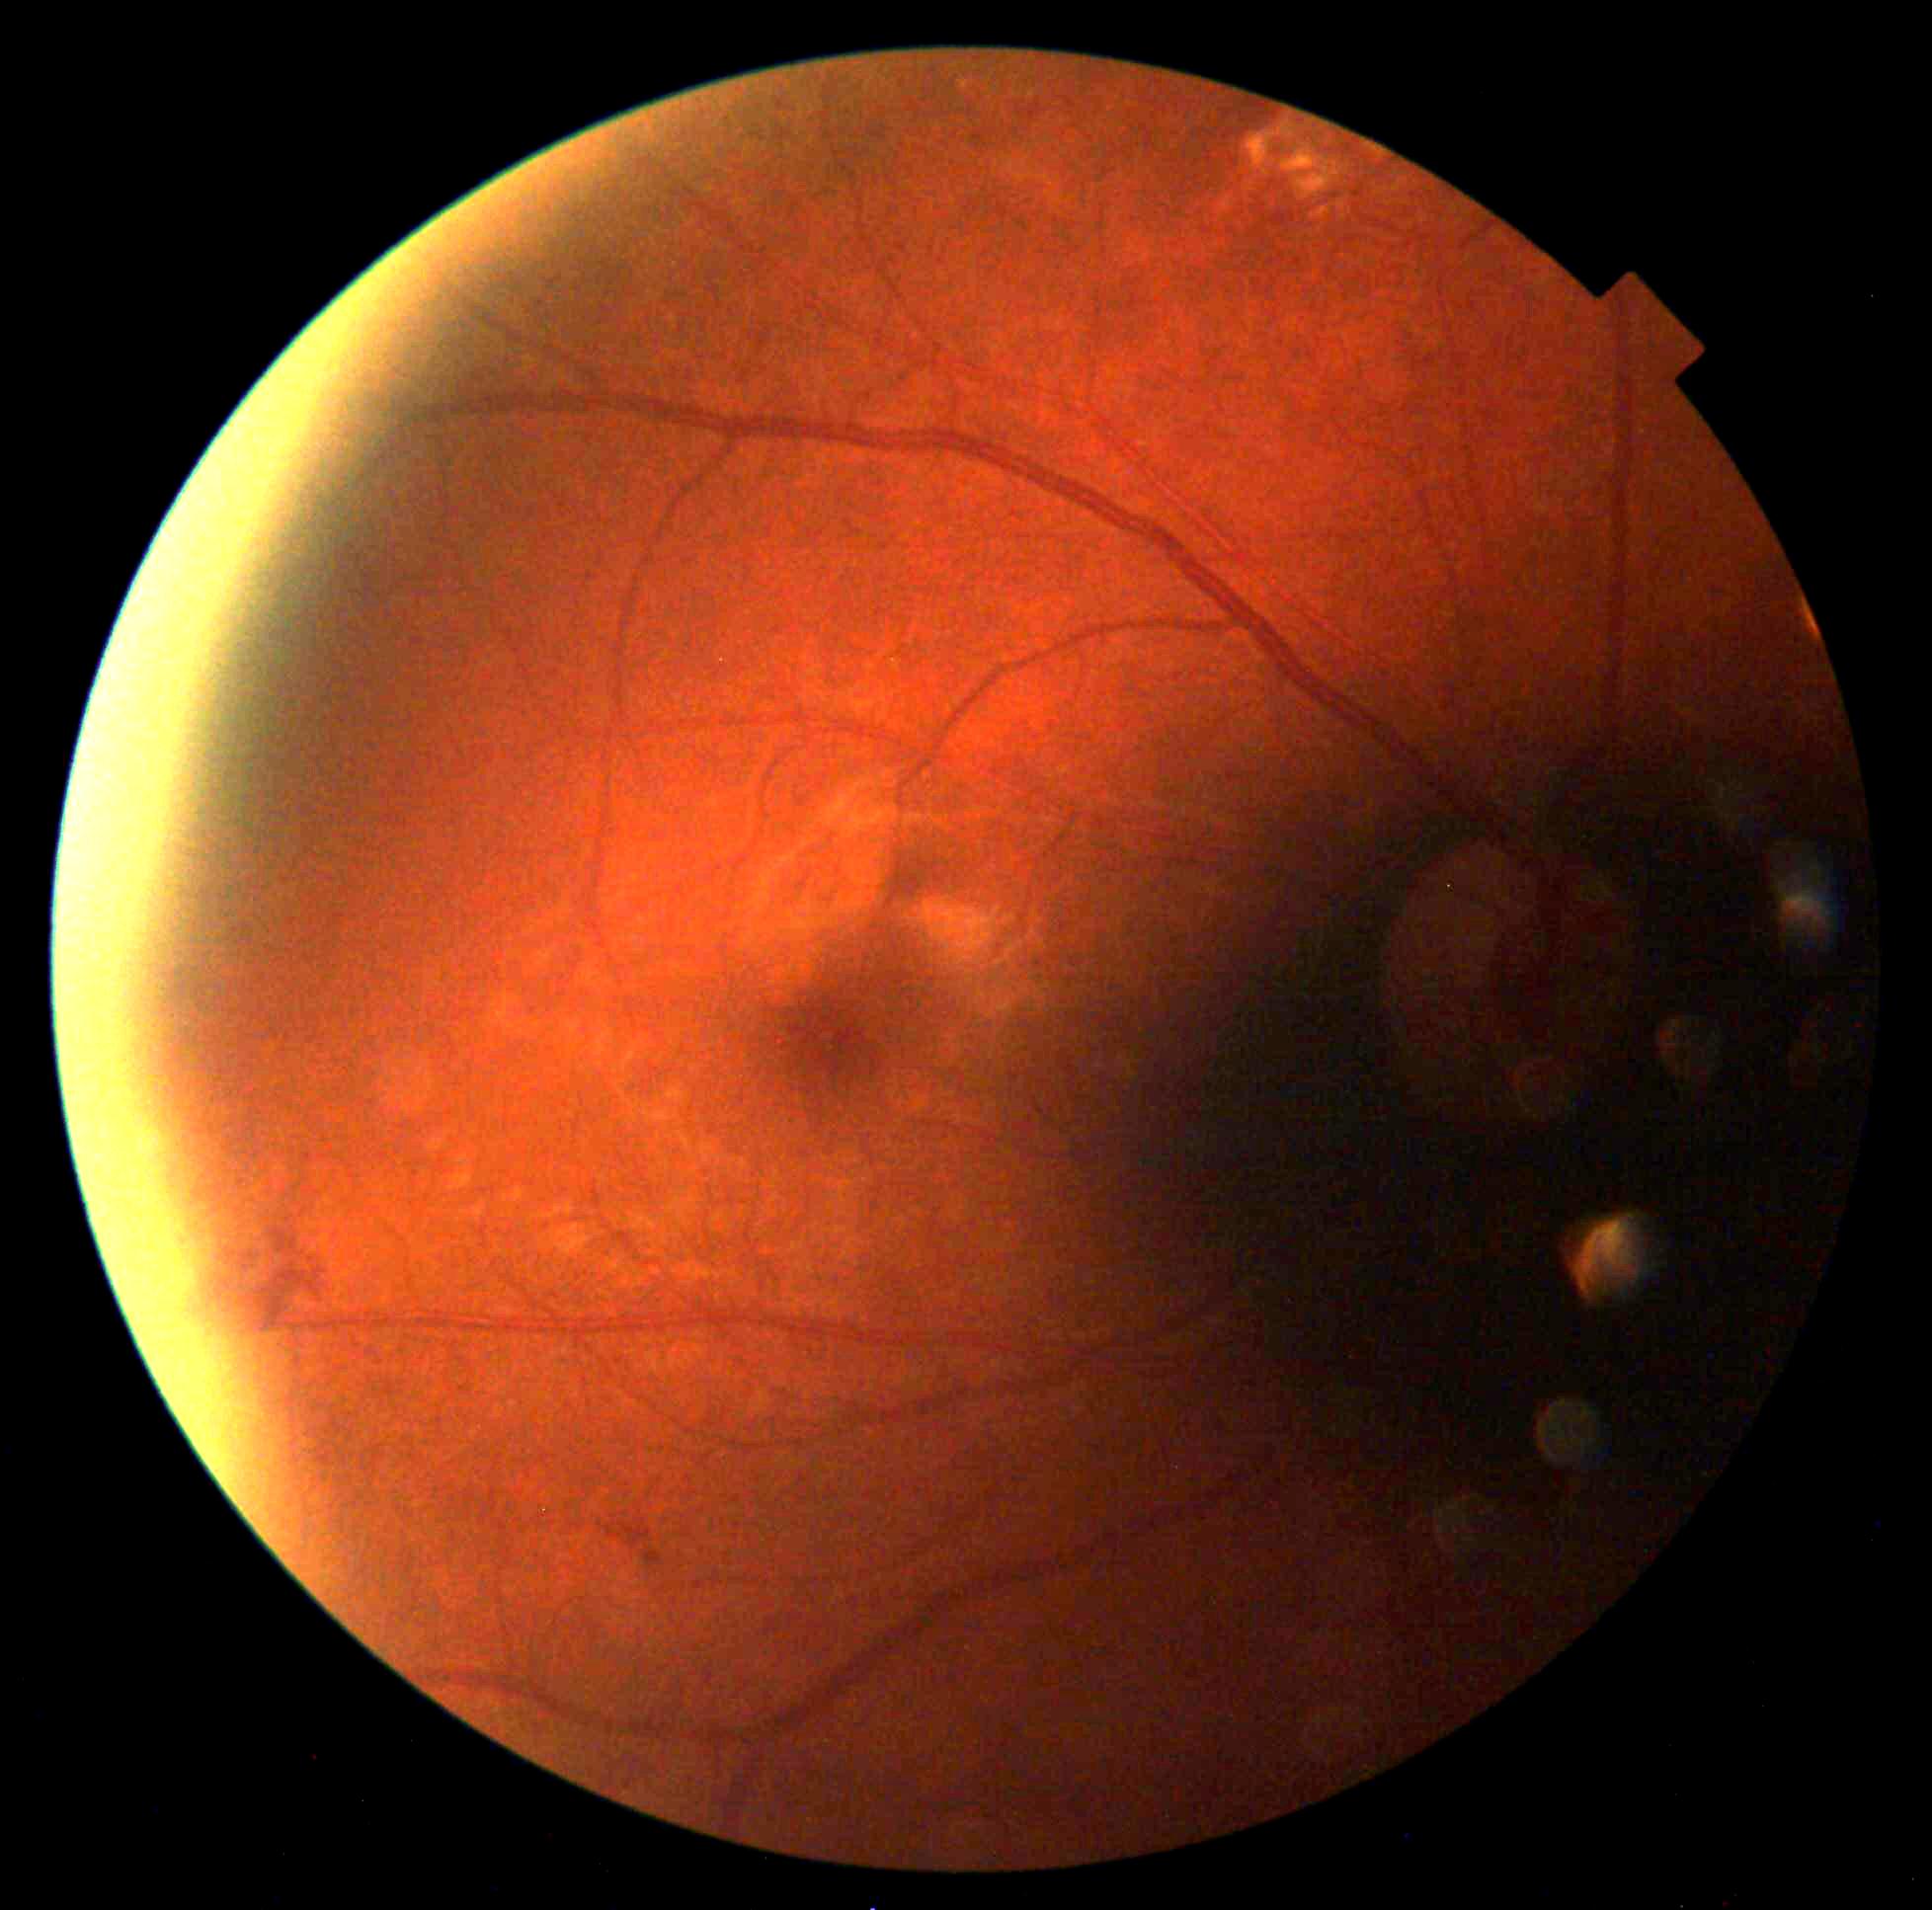 Retinopathy grade: 2 (moderate NPDR).